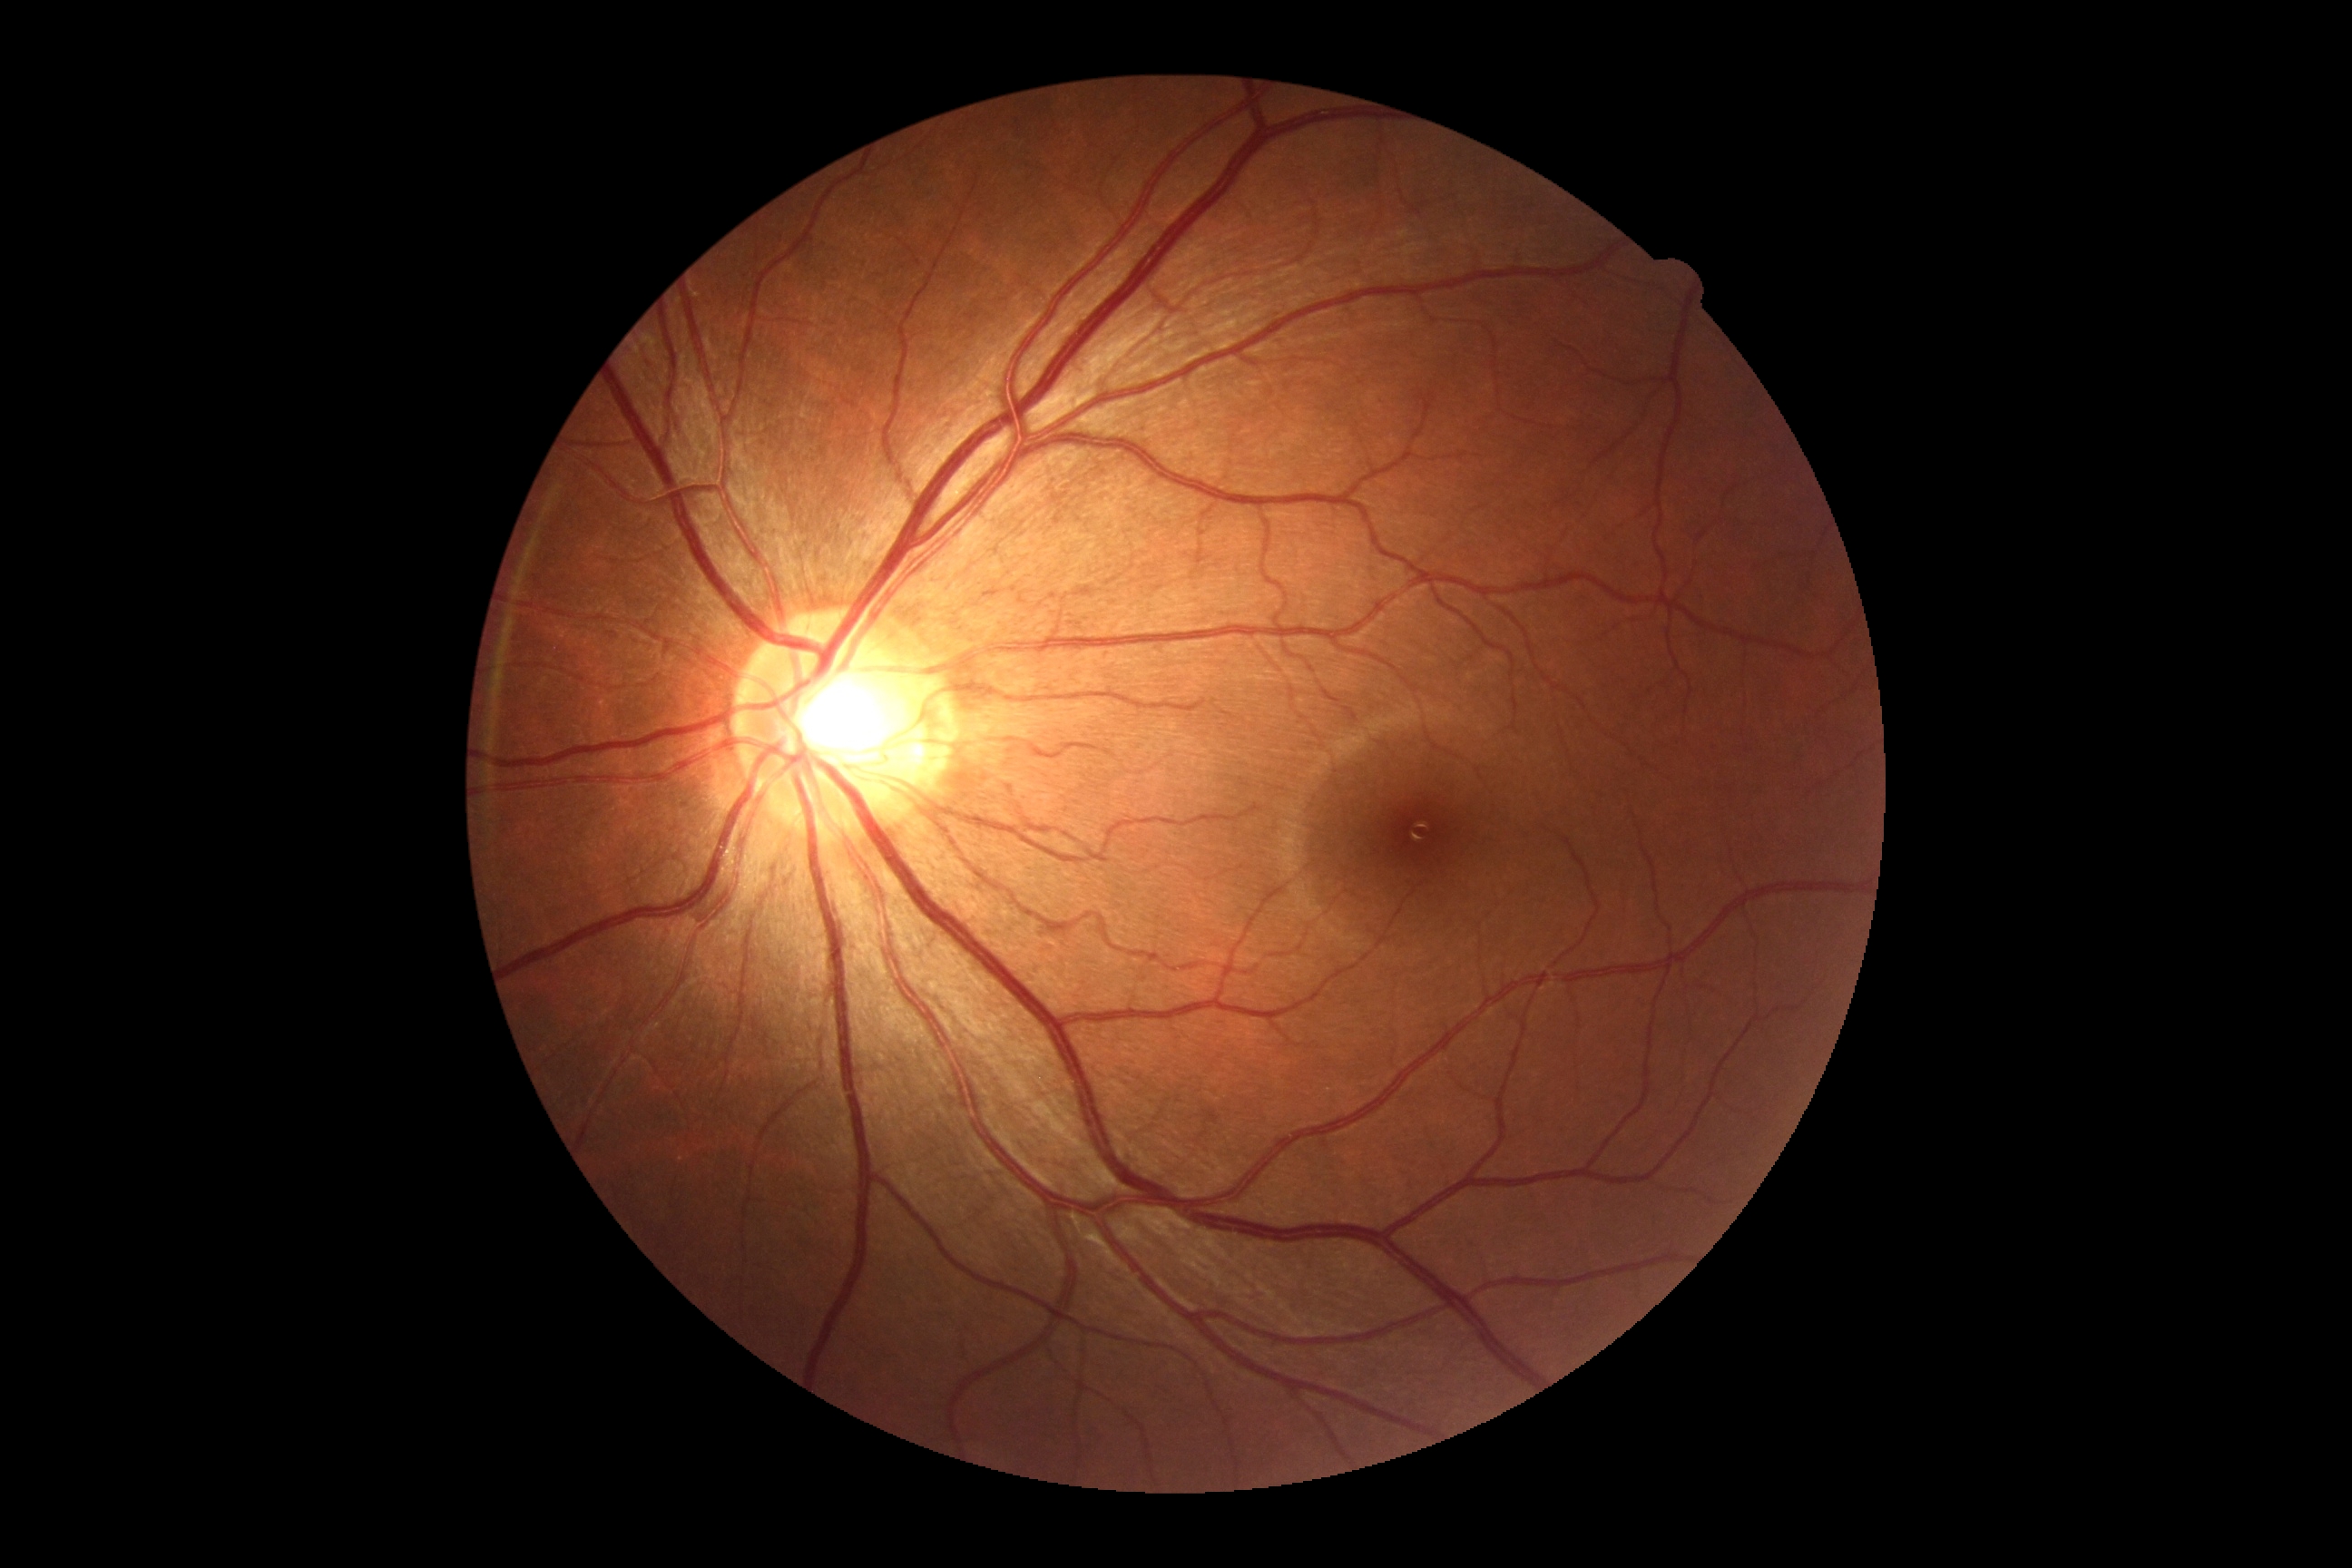
Diabetic retinopathy (DR) is no apparent diabetic retinopathy (grade 0) — no visible signs of diabetic retinopathy. No diabetic retinal disease findings.